CFP; image size 1932x1910: 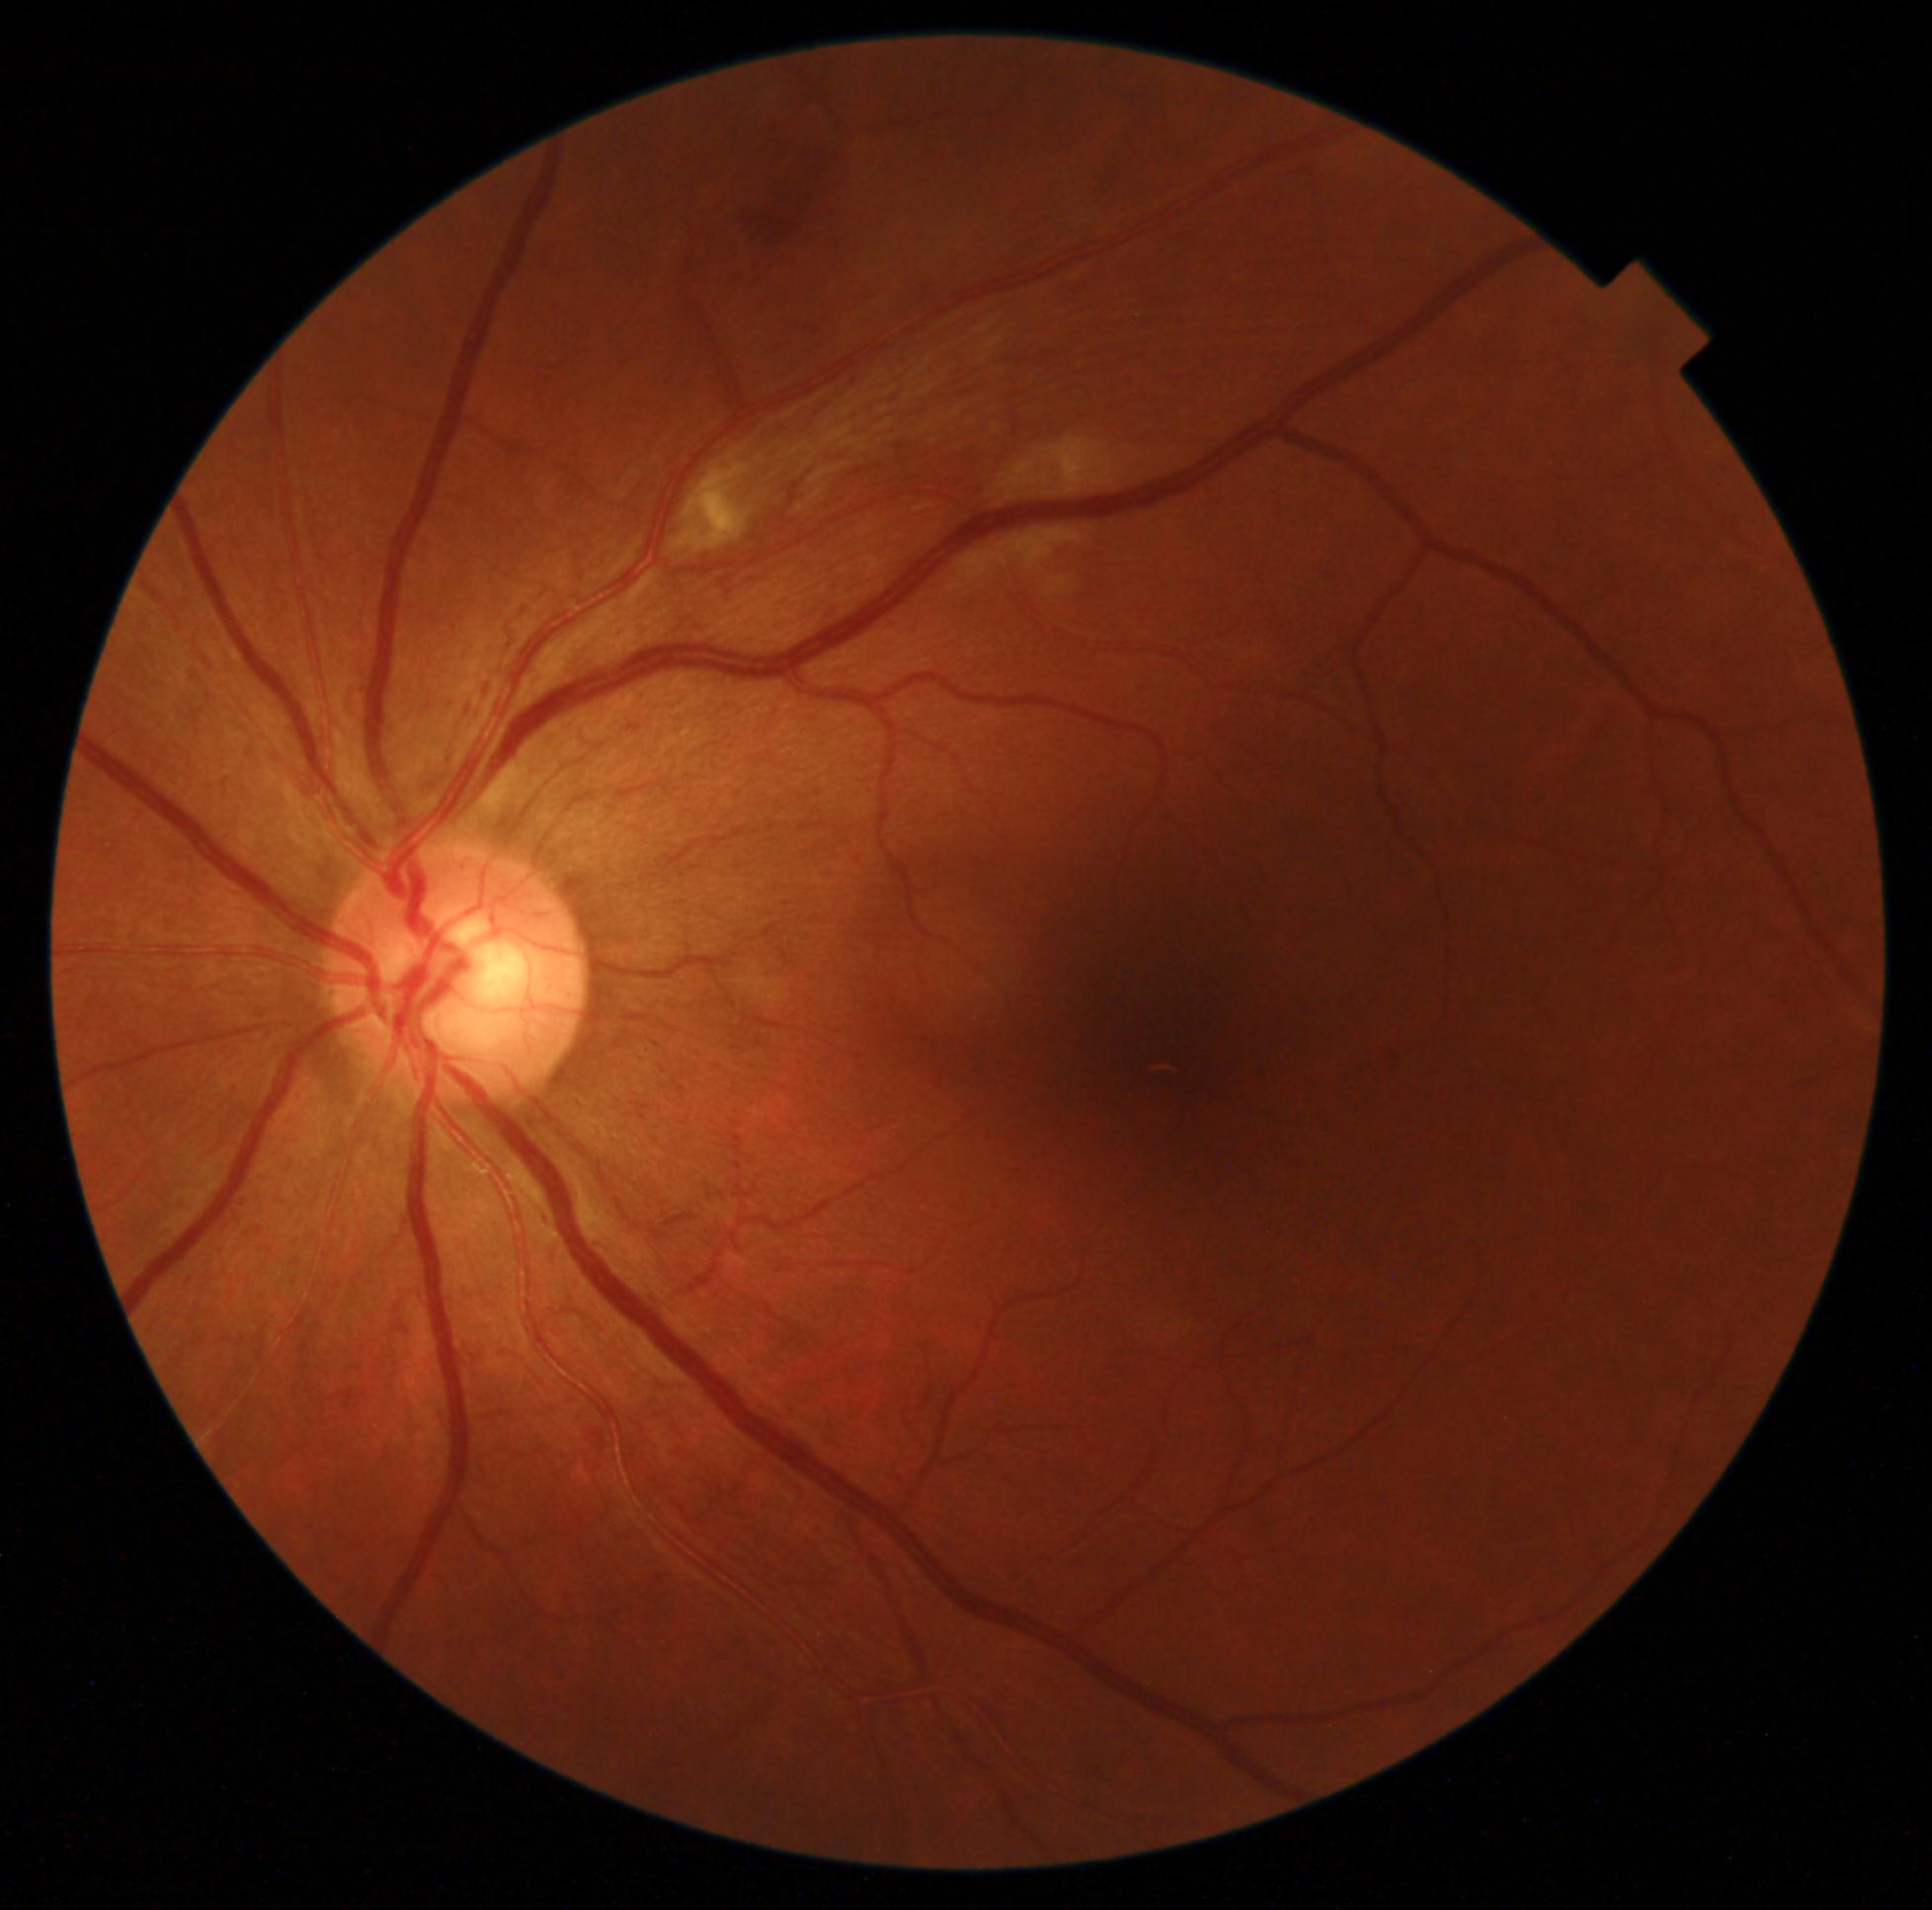 diabetic retinopathy grade: 2/4.